Image size 2352x1568; 45-degree field of view.
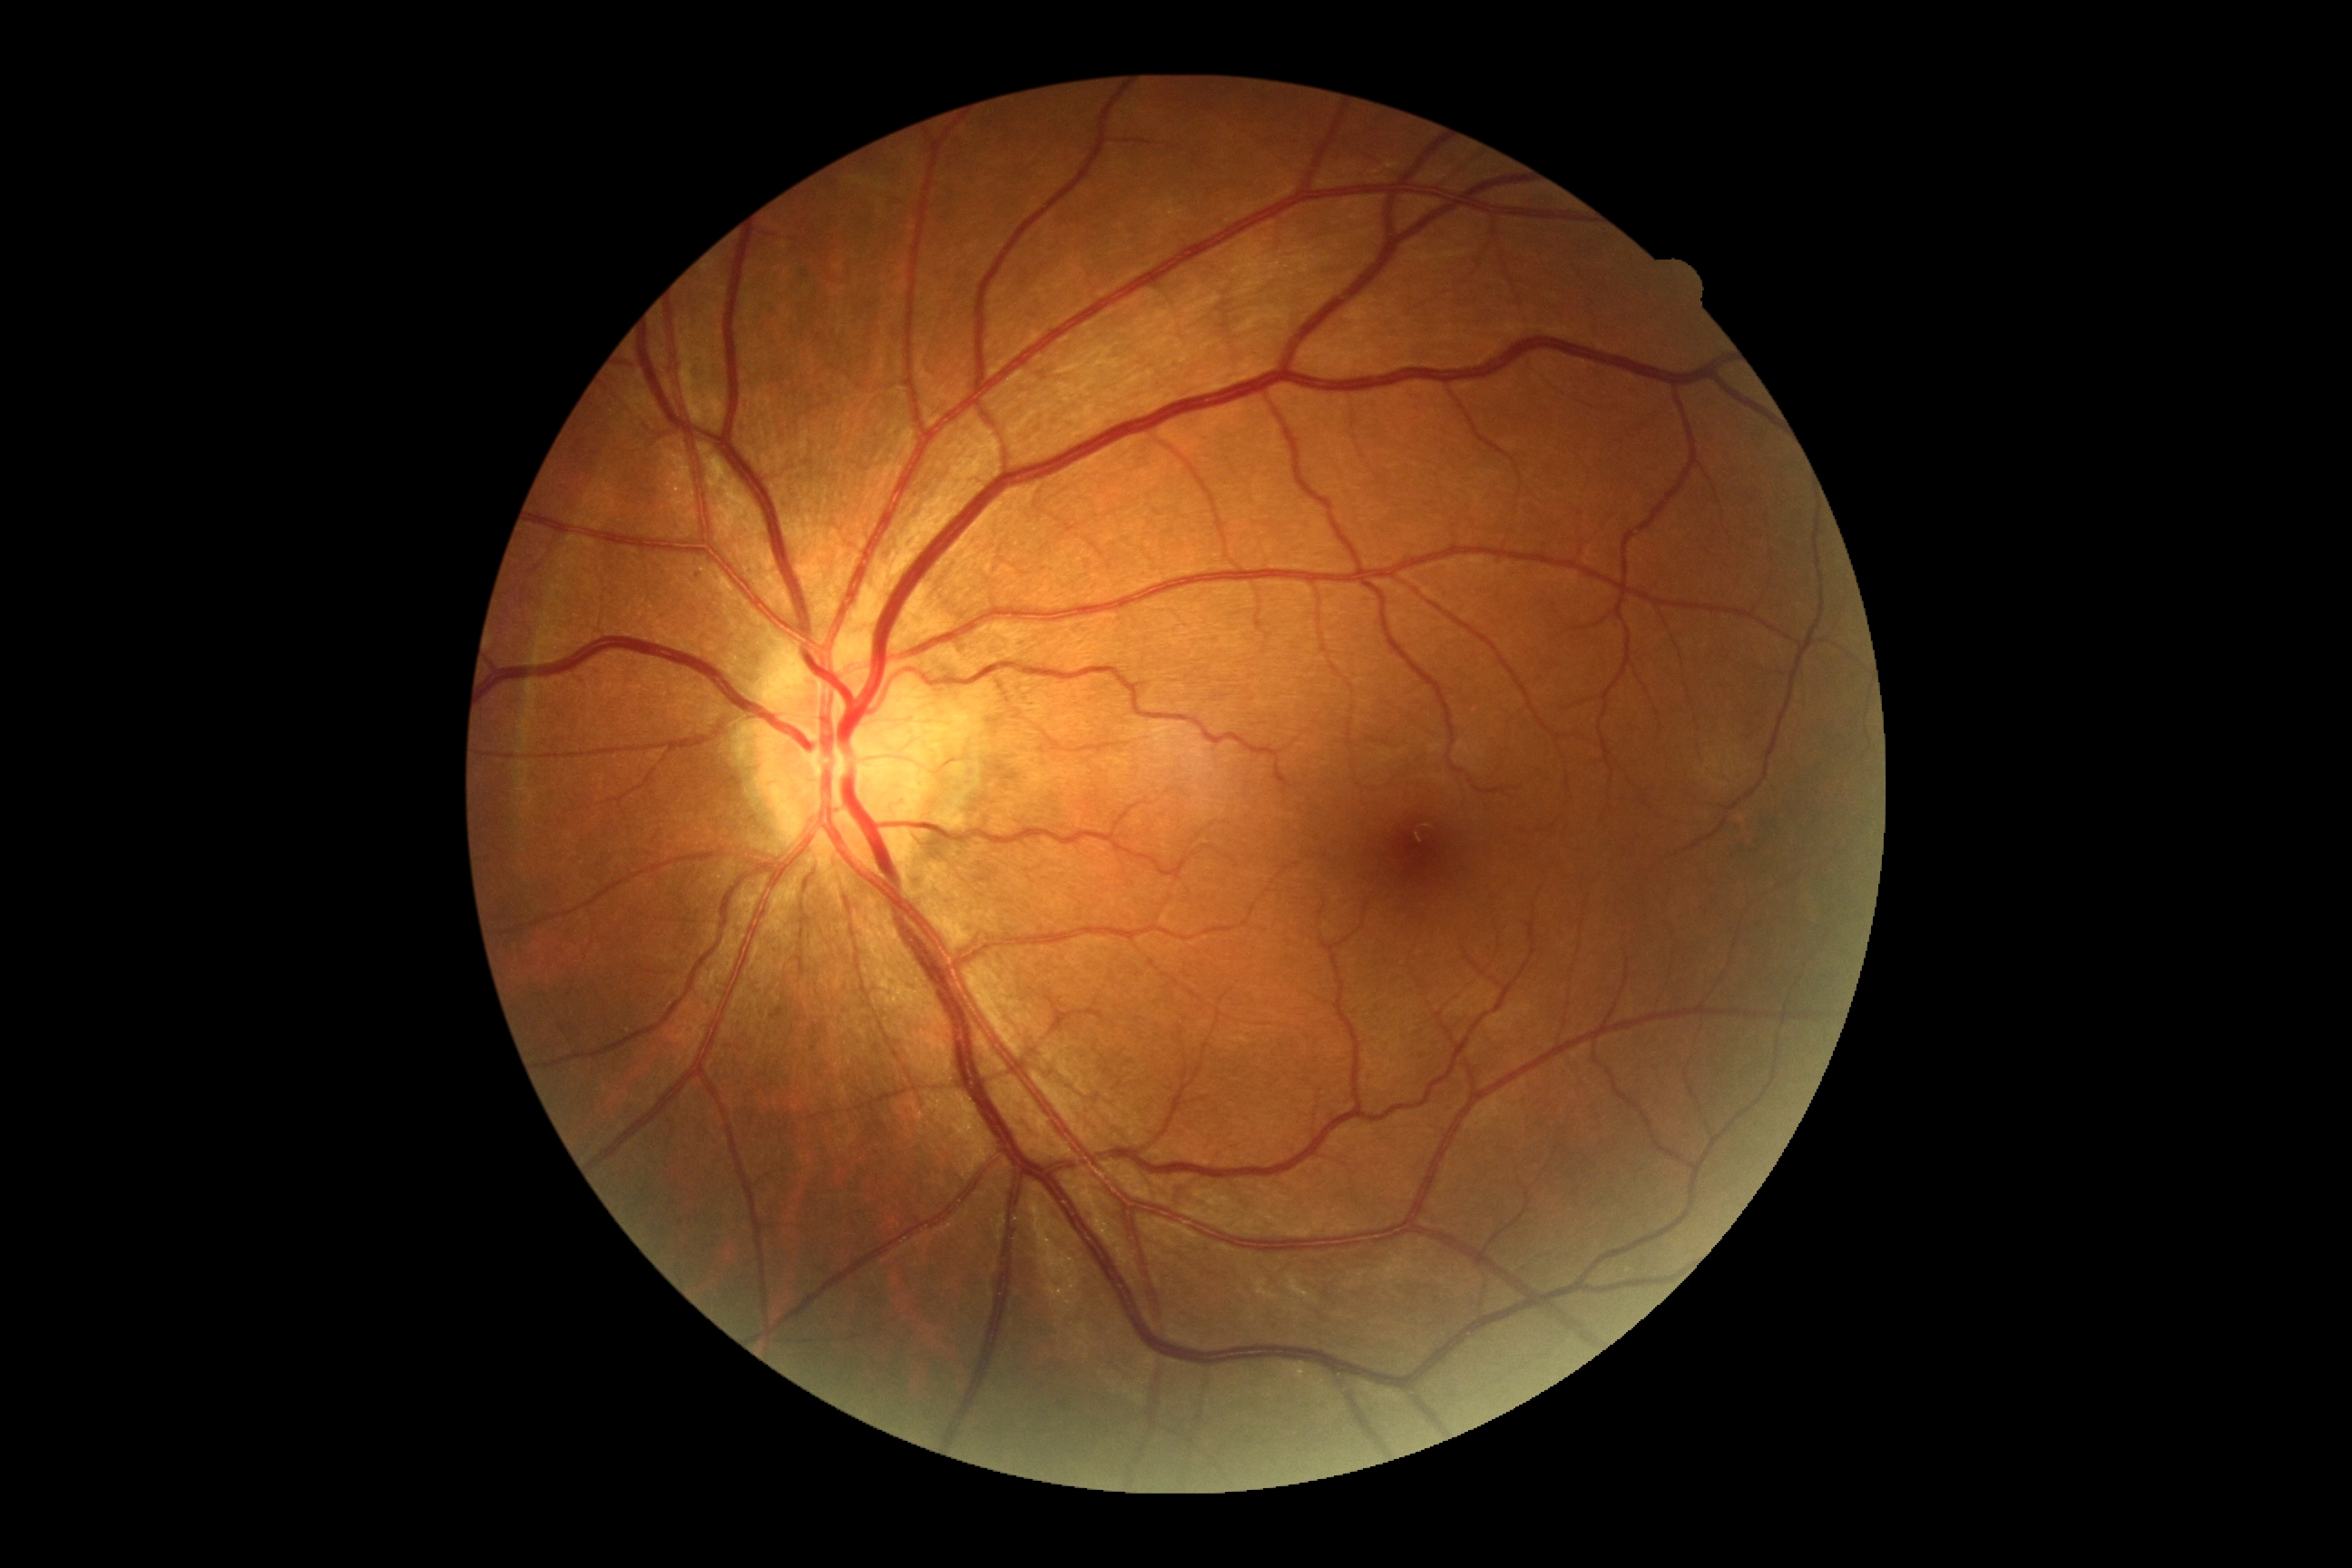

Diabetic retinopathy: grade 0 (no apparent retinopathy). No diabetic retinal disease findings.